RetCam wide-field infant fundus image:
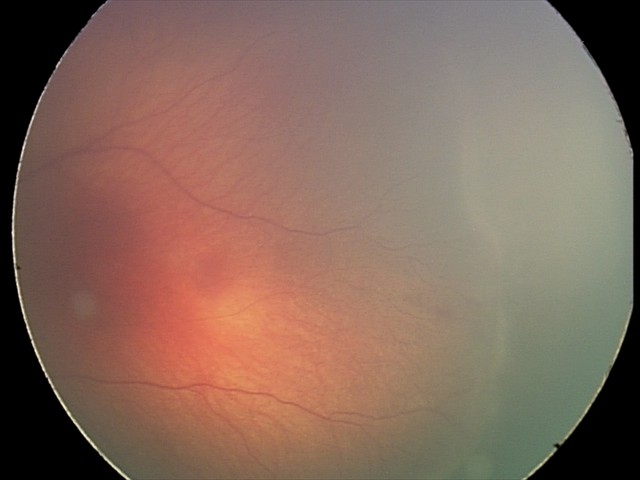

No plus disease. Series diagnosed as ROP stage 2.